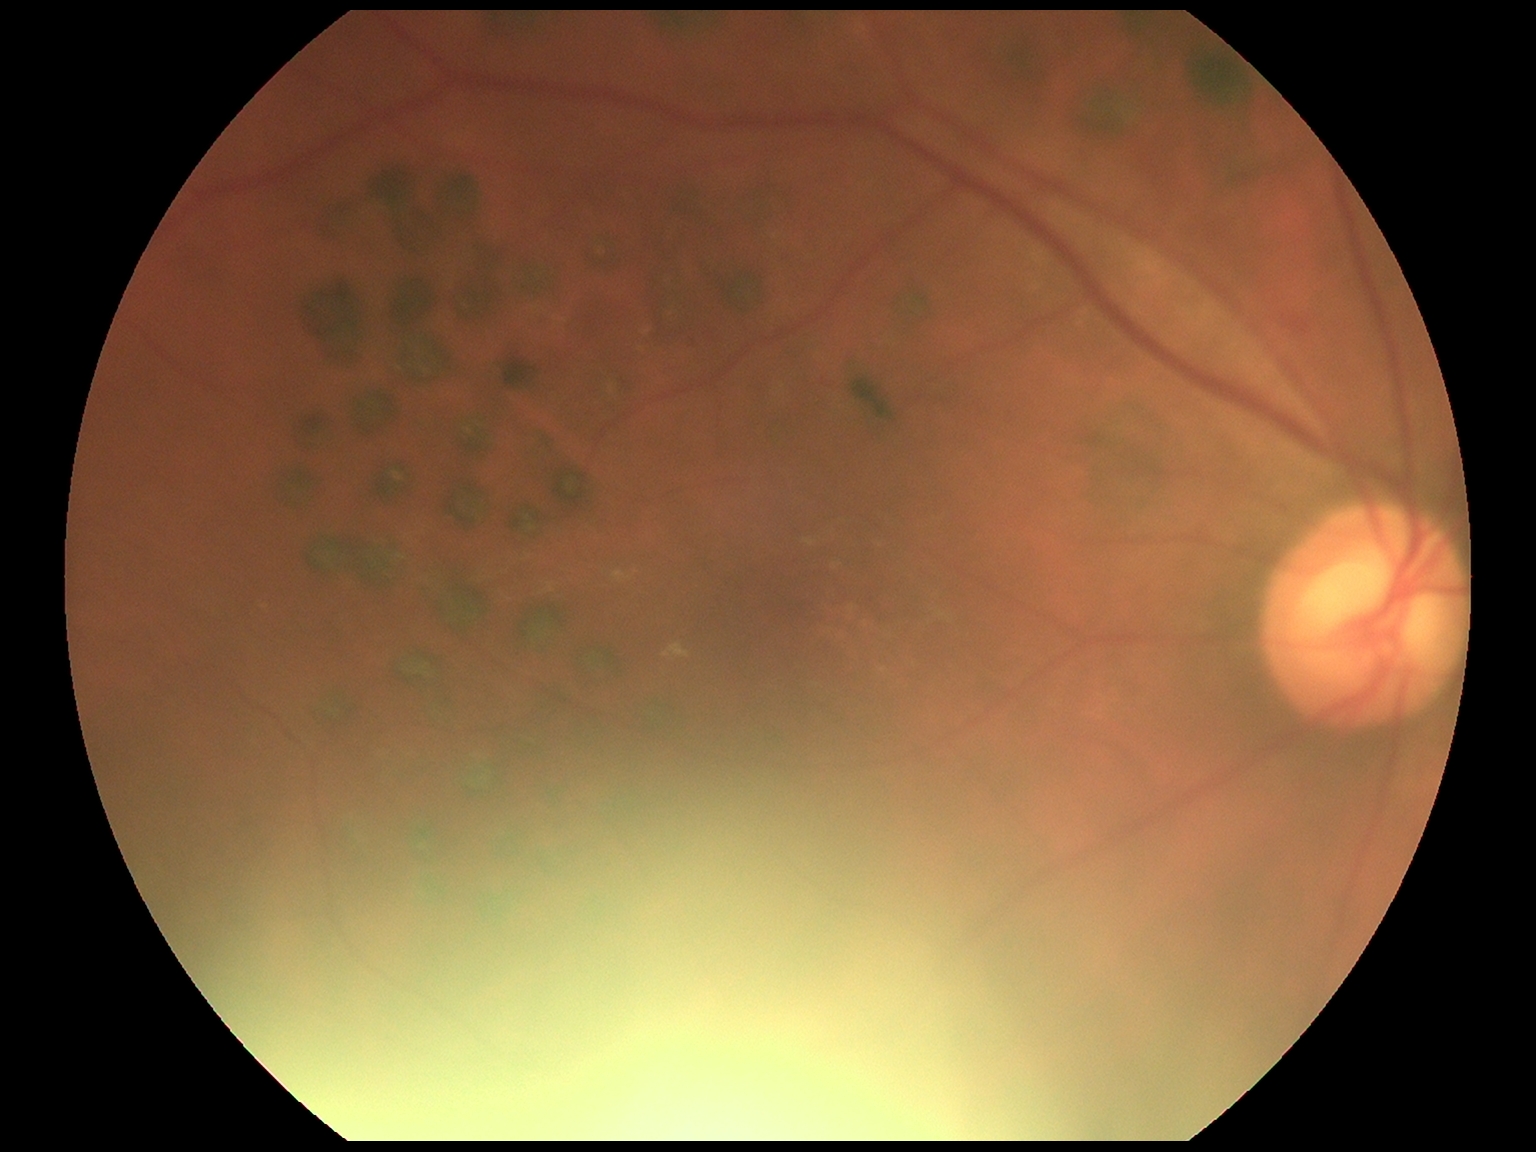 DR severity: moderate NPDR (grade 2).